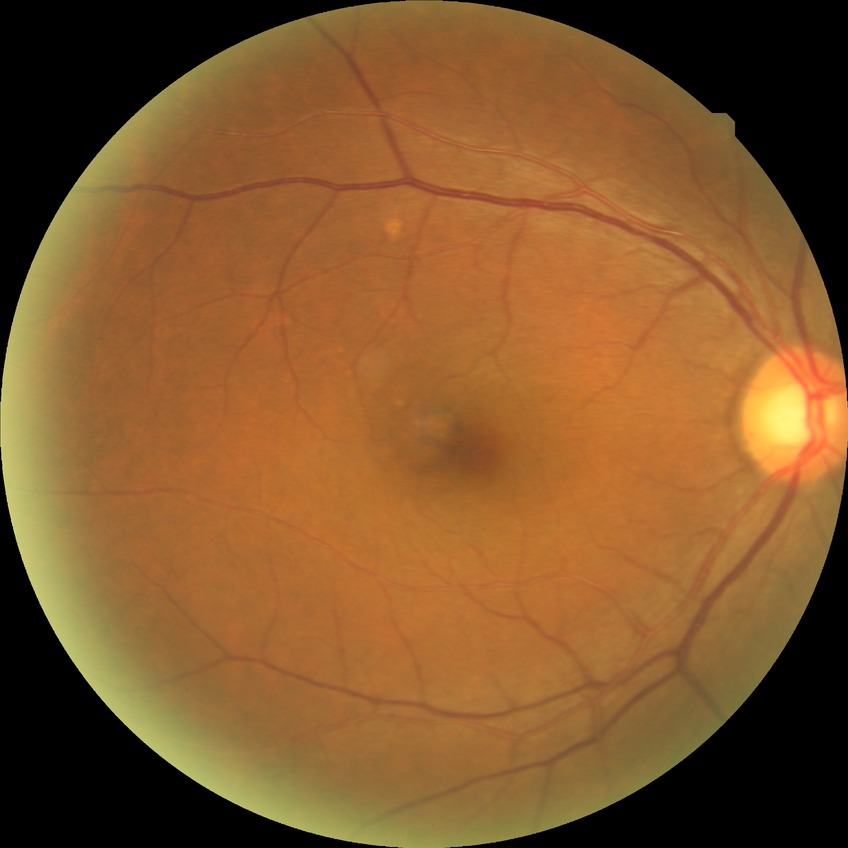 Assessment:
– DR impression: negative for DR
– Davis stage: NDR